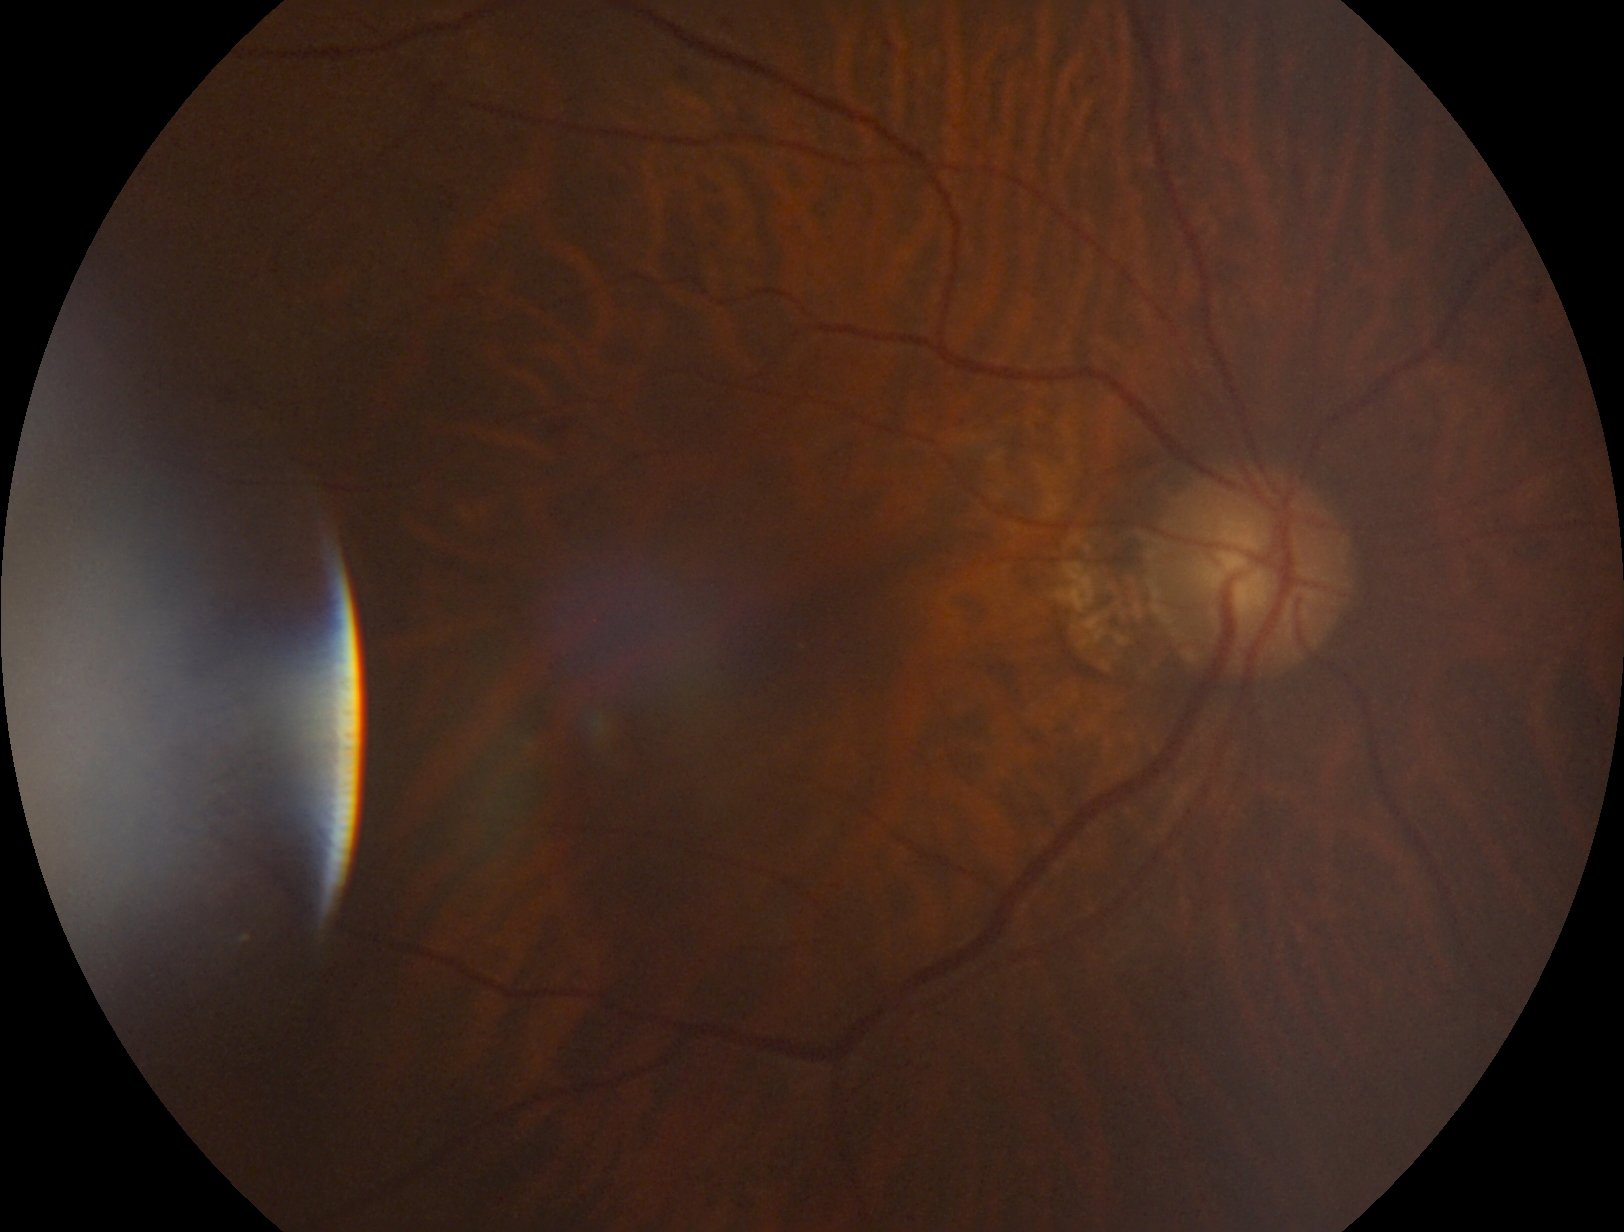

dr_grade: grade 2 (moderate NPDR)